2048x1536px:
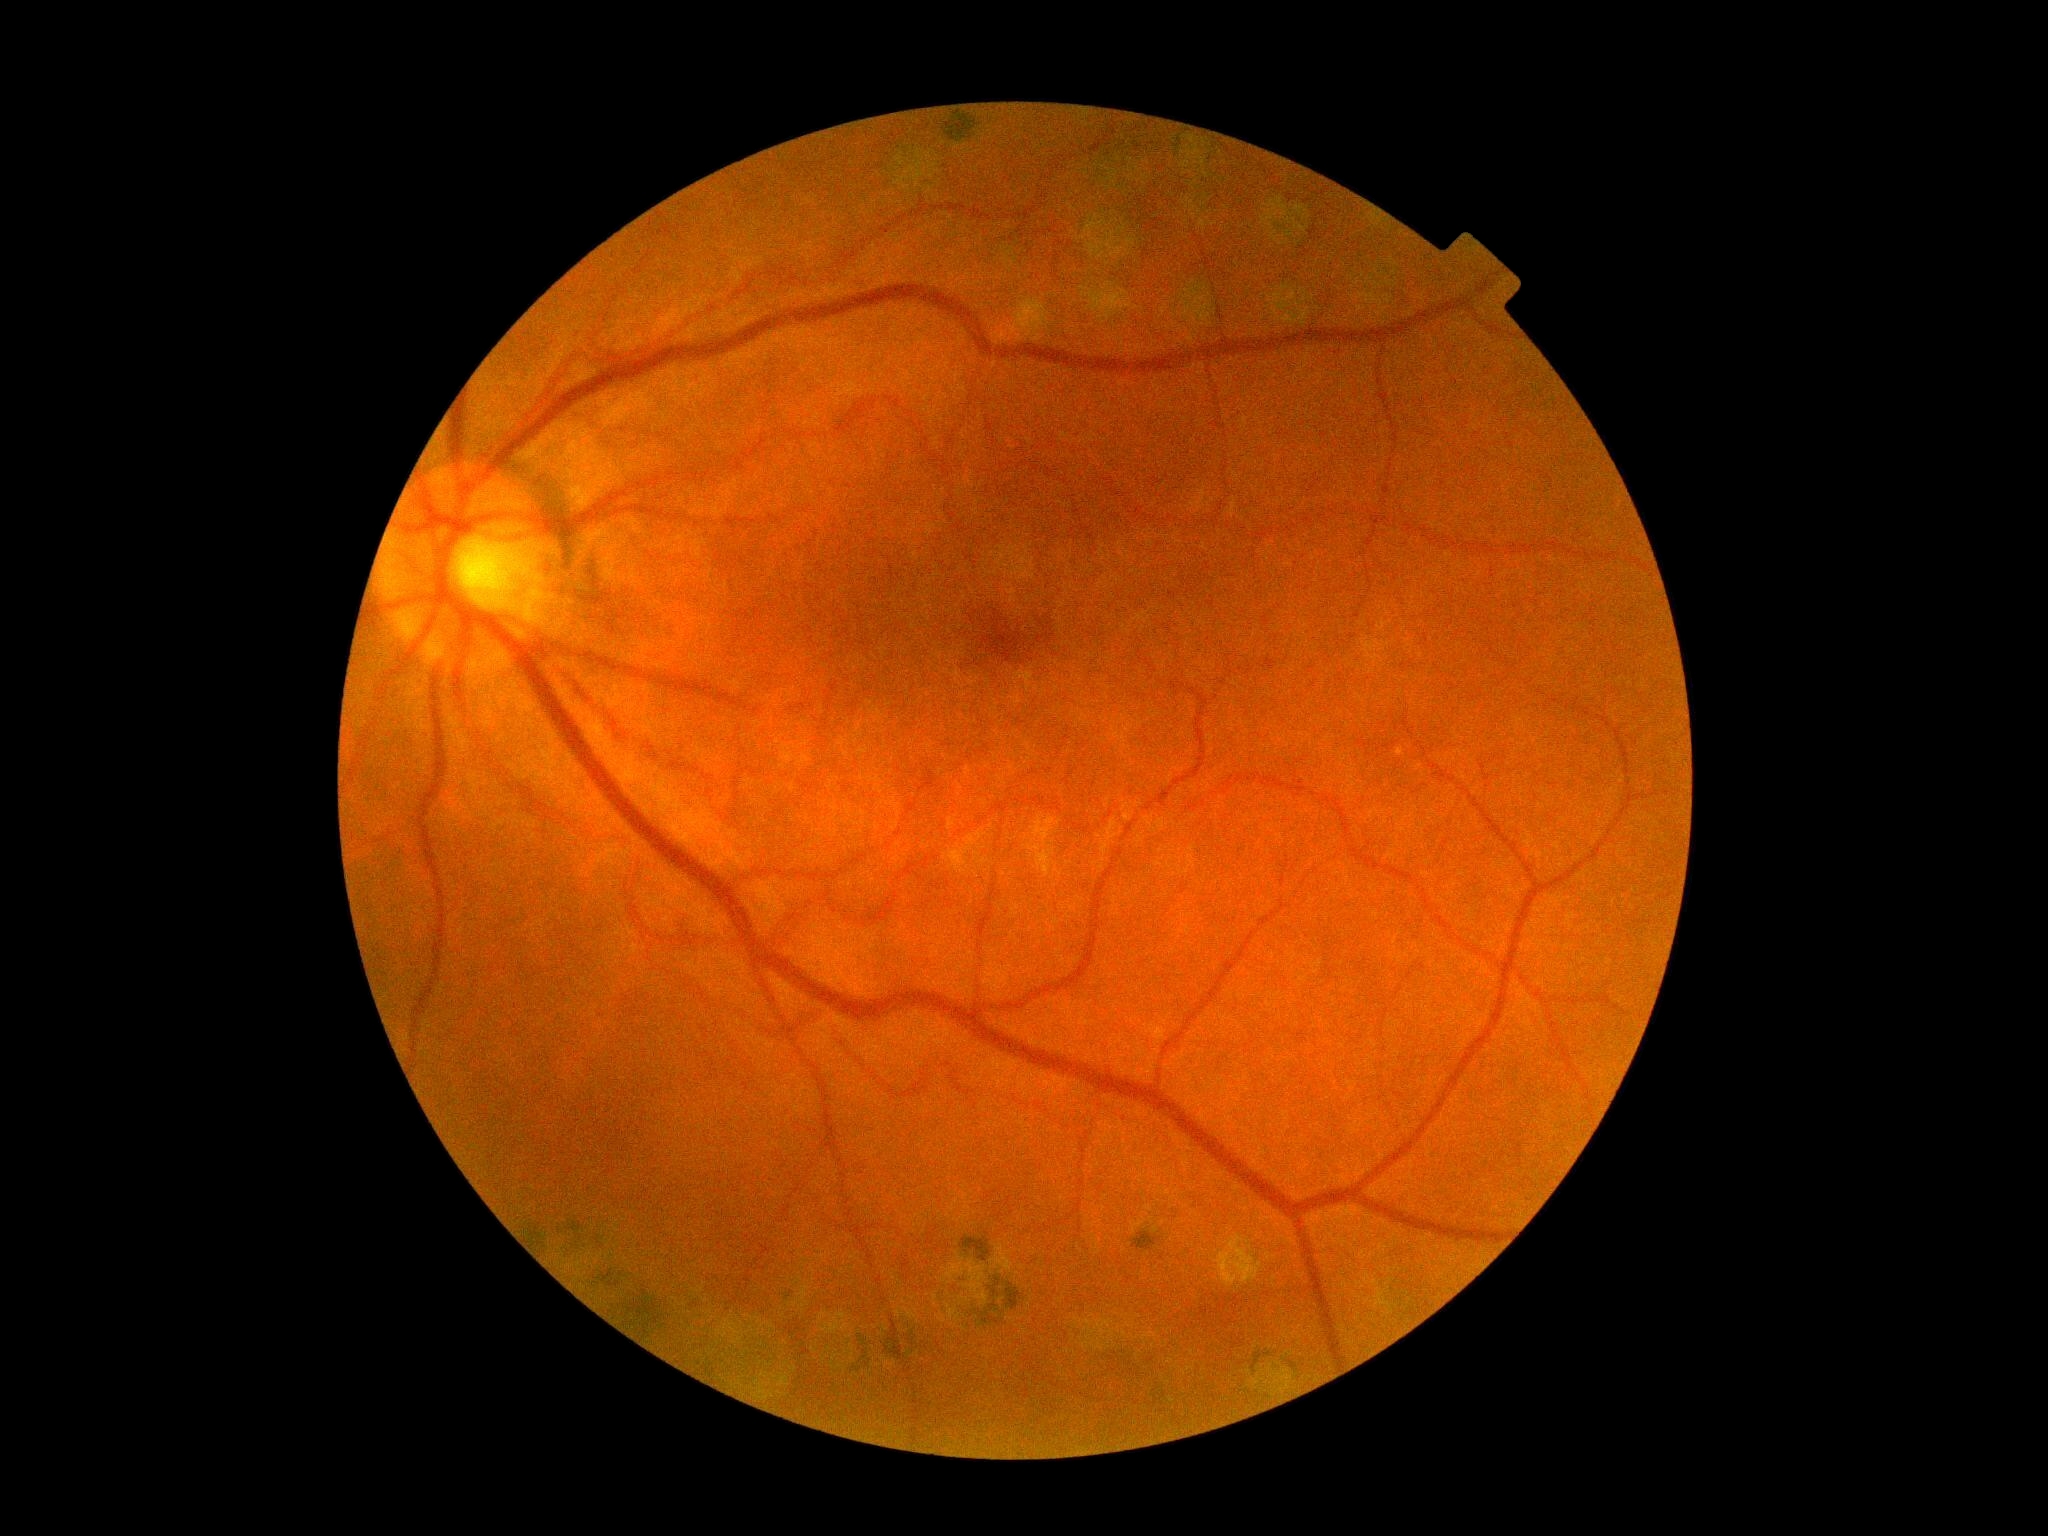   dr_grade: grade 0 (no apparent retinopathy)